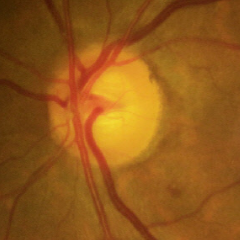

Optic disc photograph demonstrating early glaucoma.